2352 x 1568 pixels. 45-degree field of view.
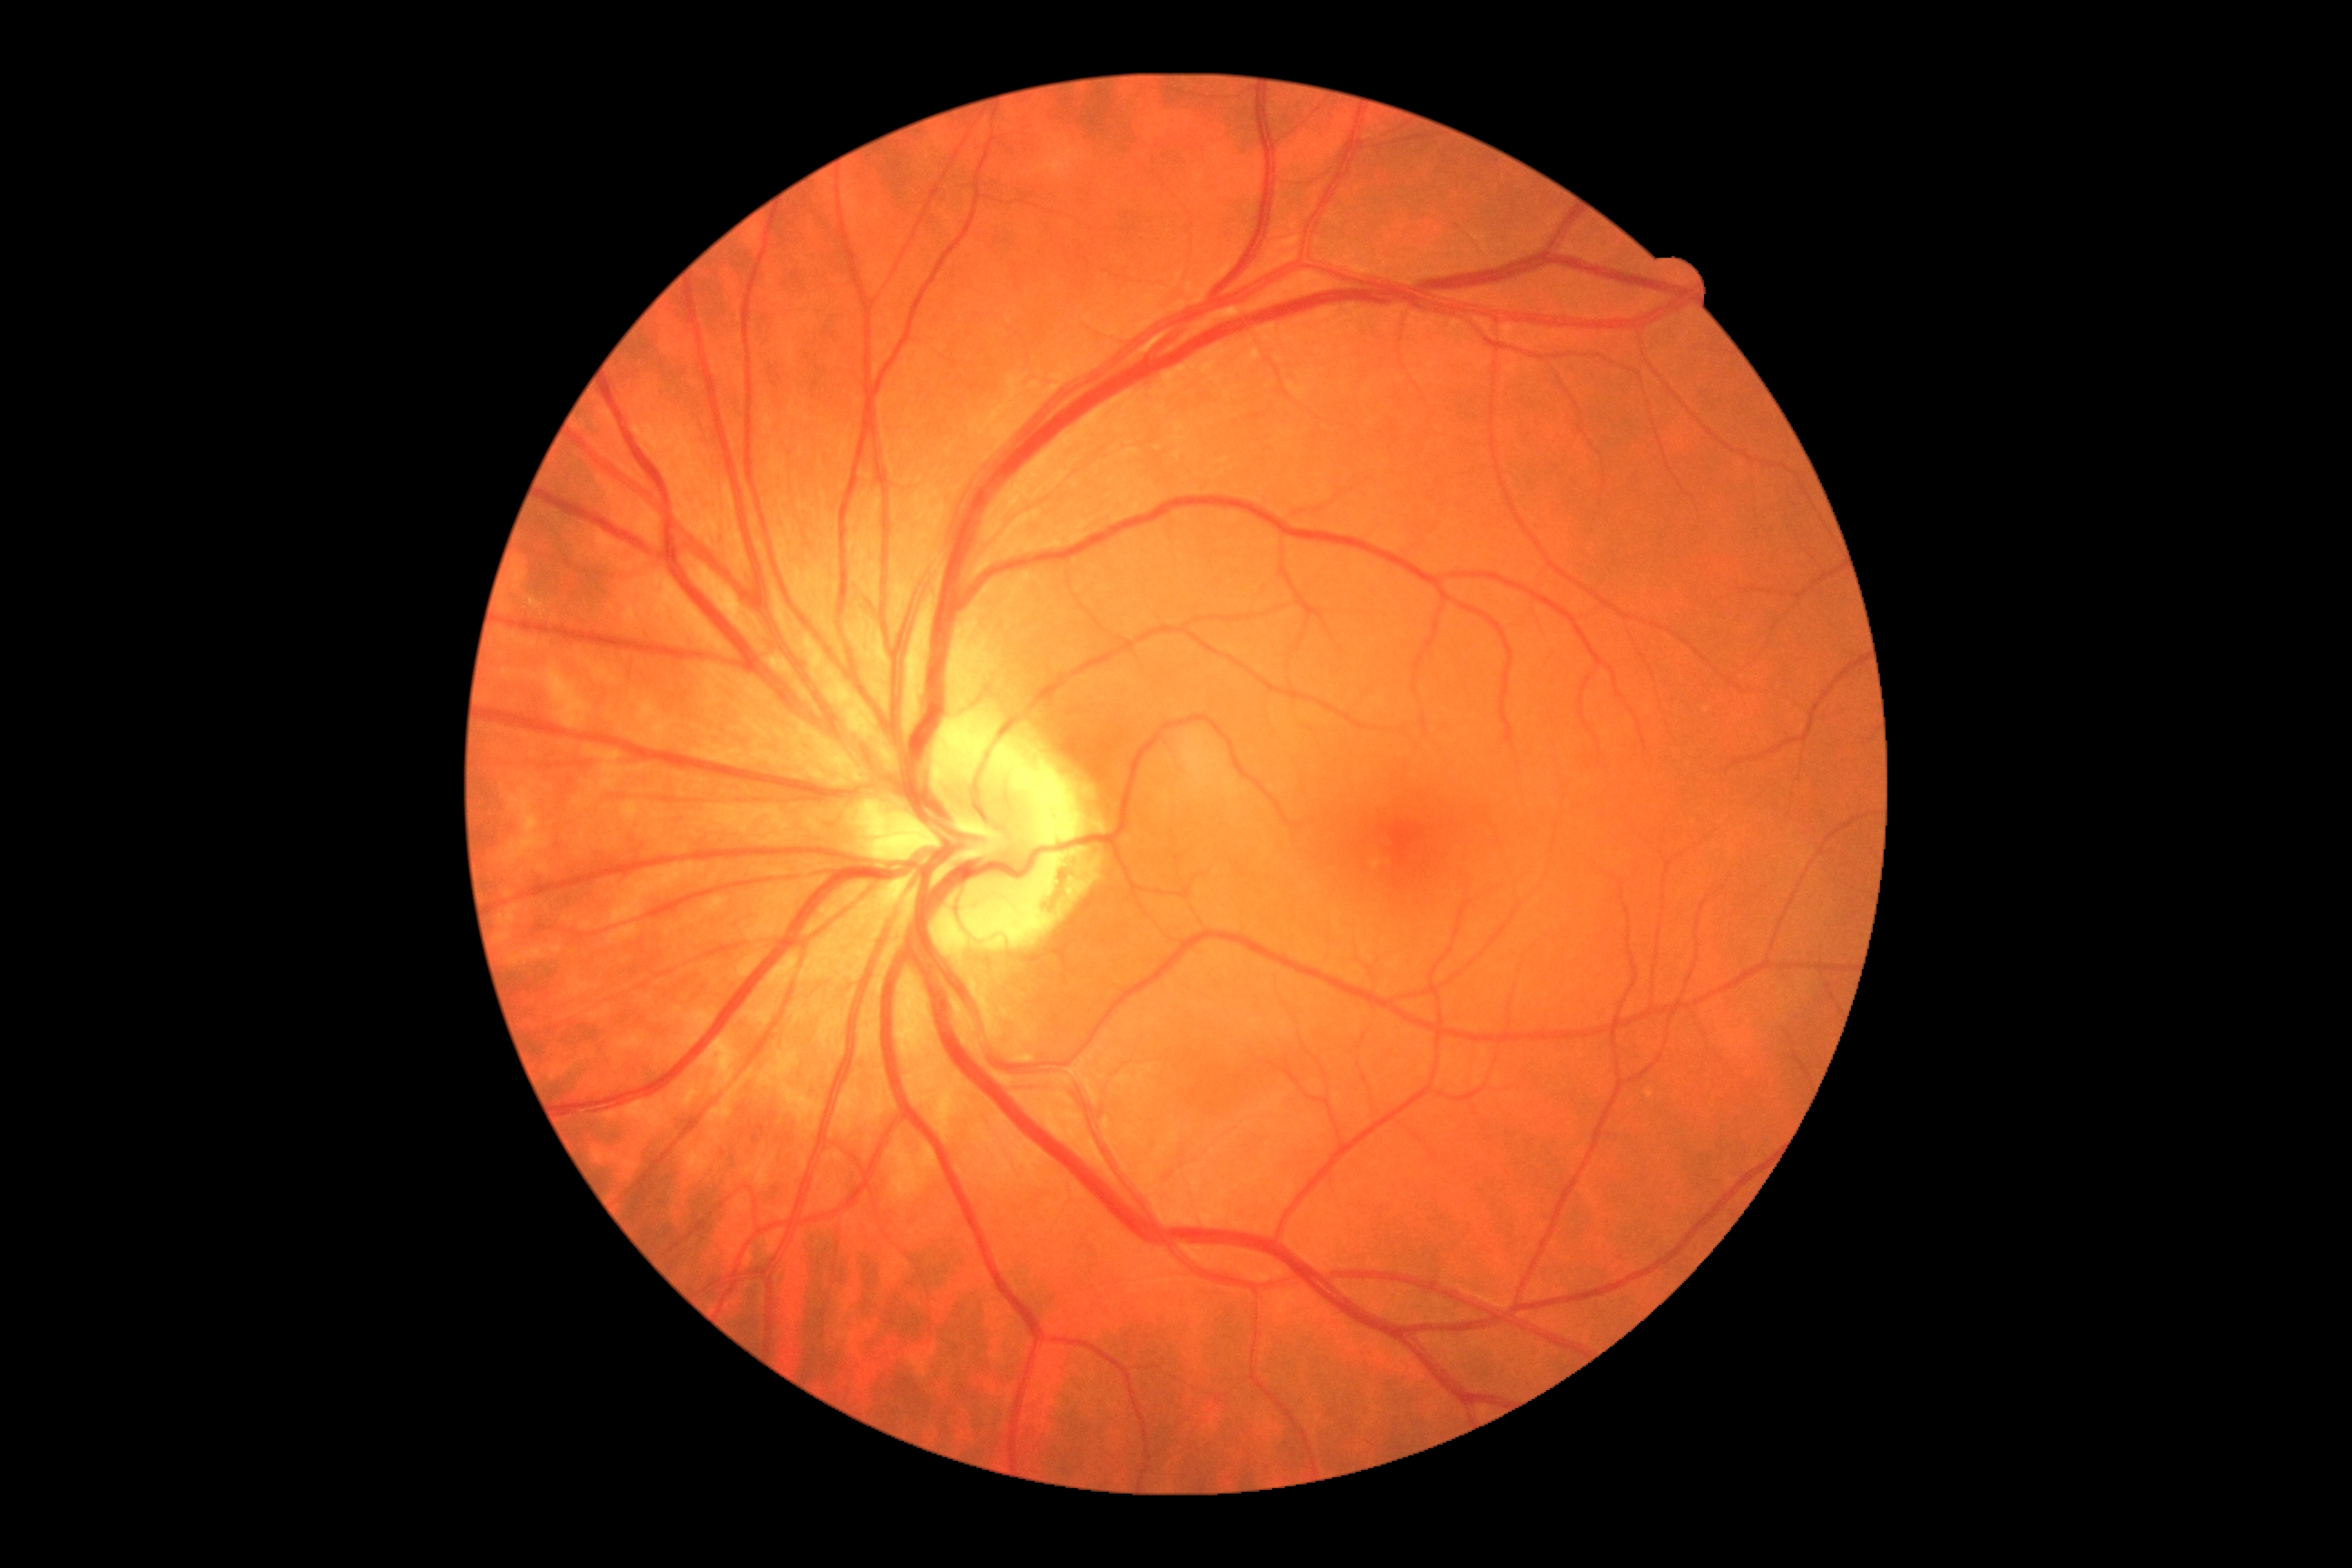
No DR findings. Diabetic retinopathy (DR) is grade 0.